Graded on the modified Davis scale — 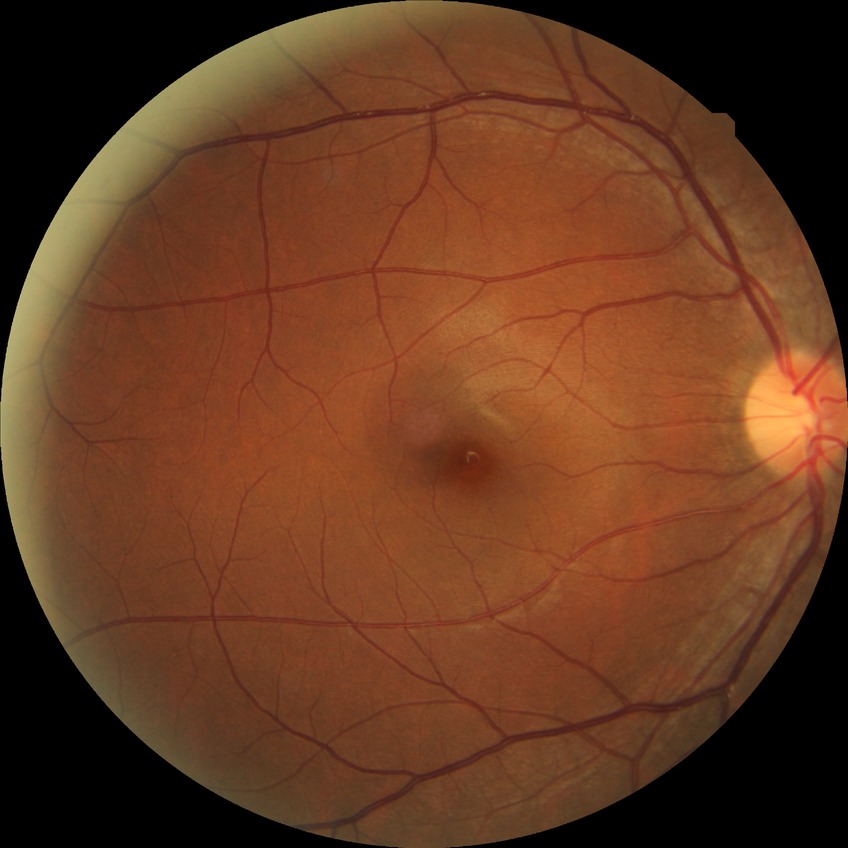
  davis_grade: simple diabetic retinopathy